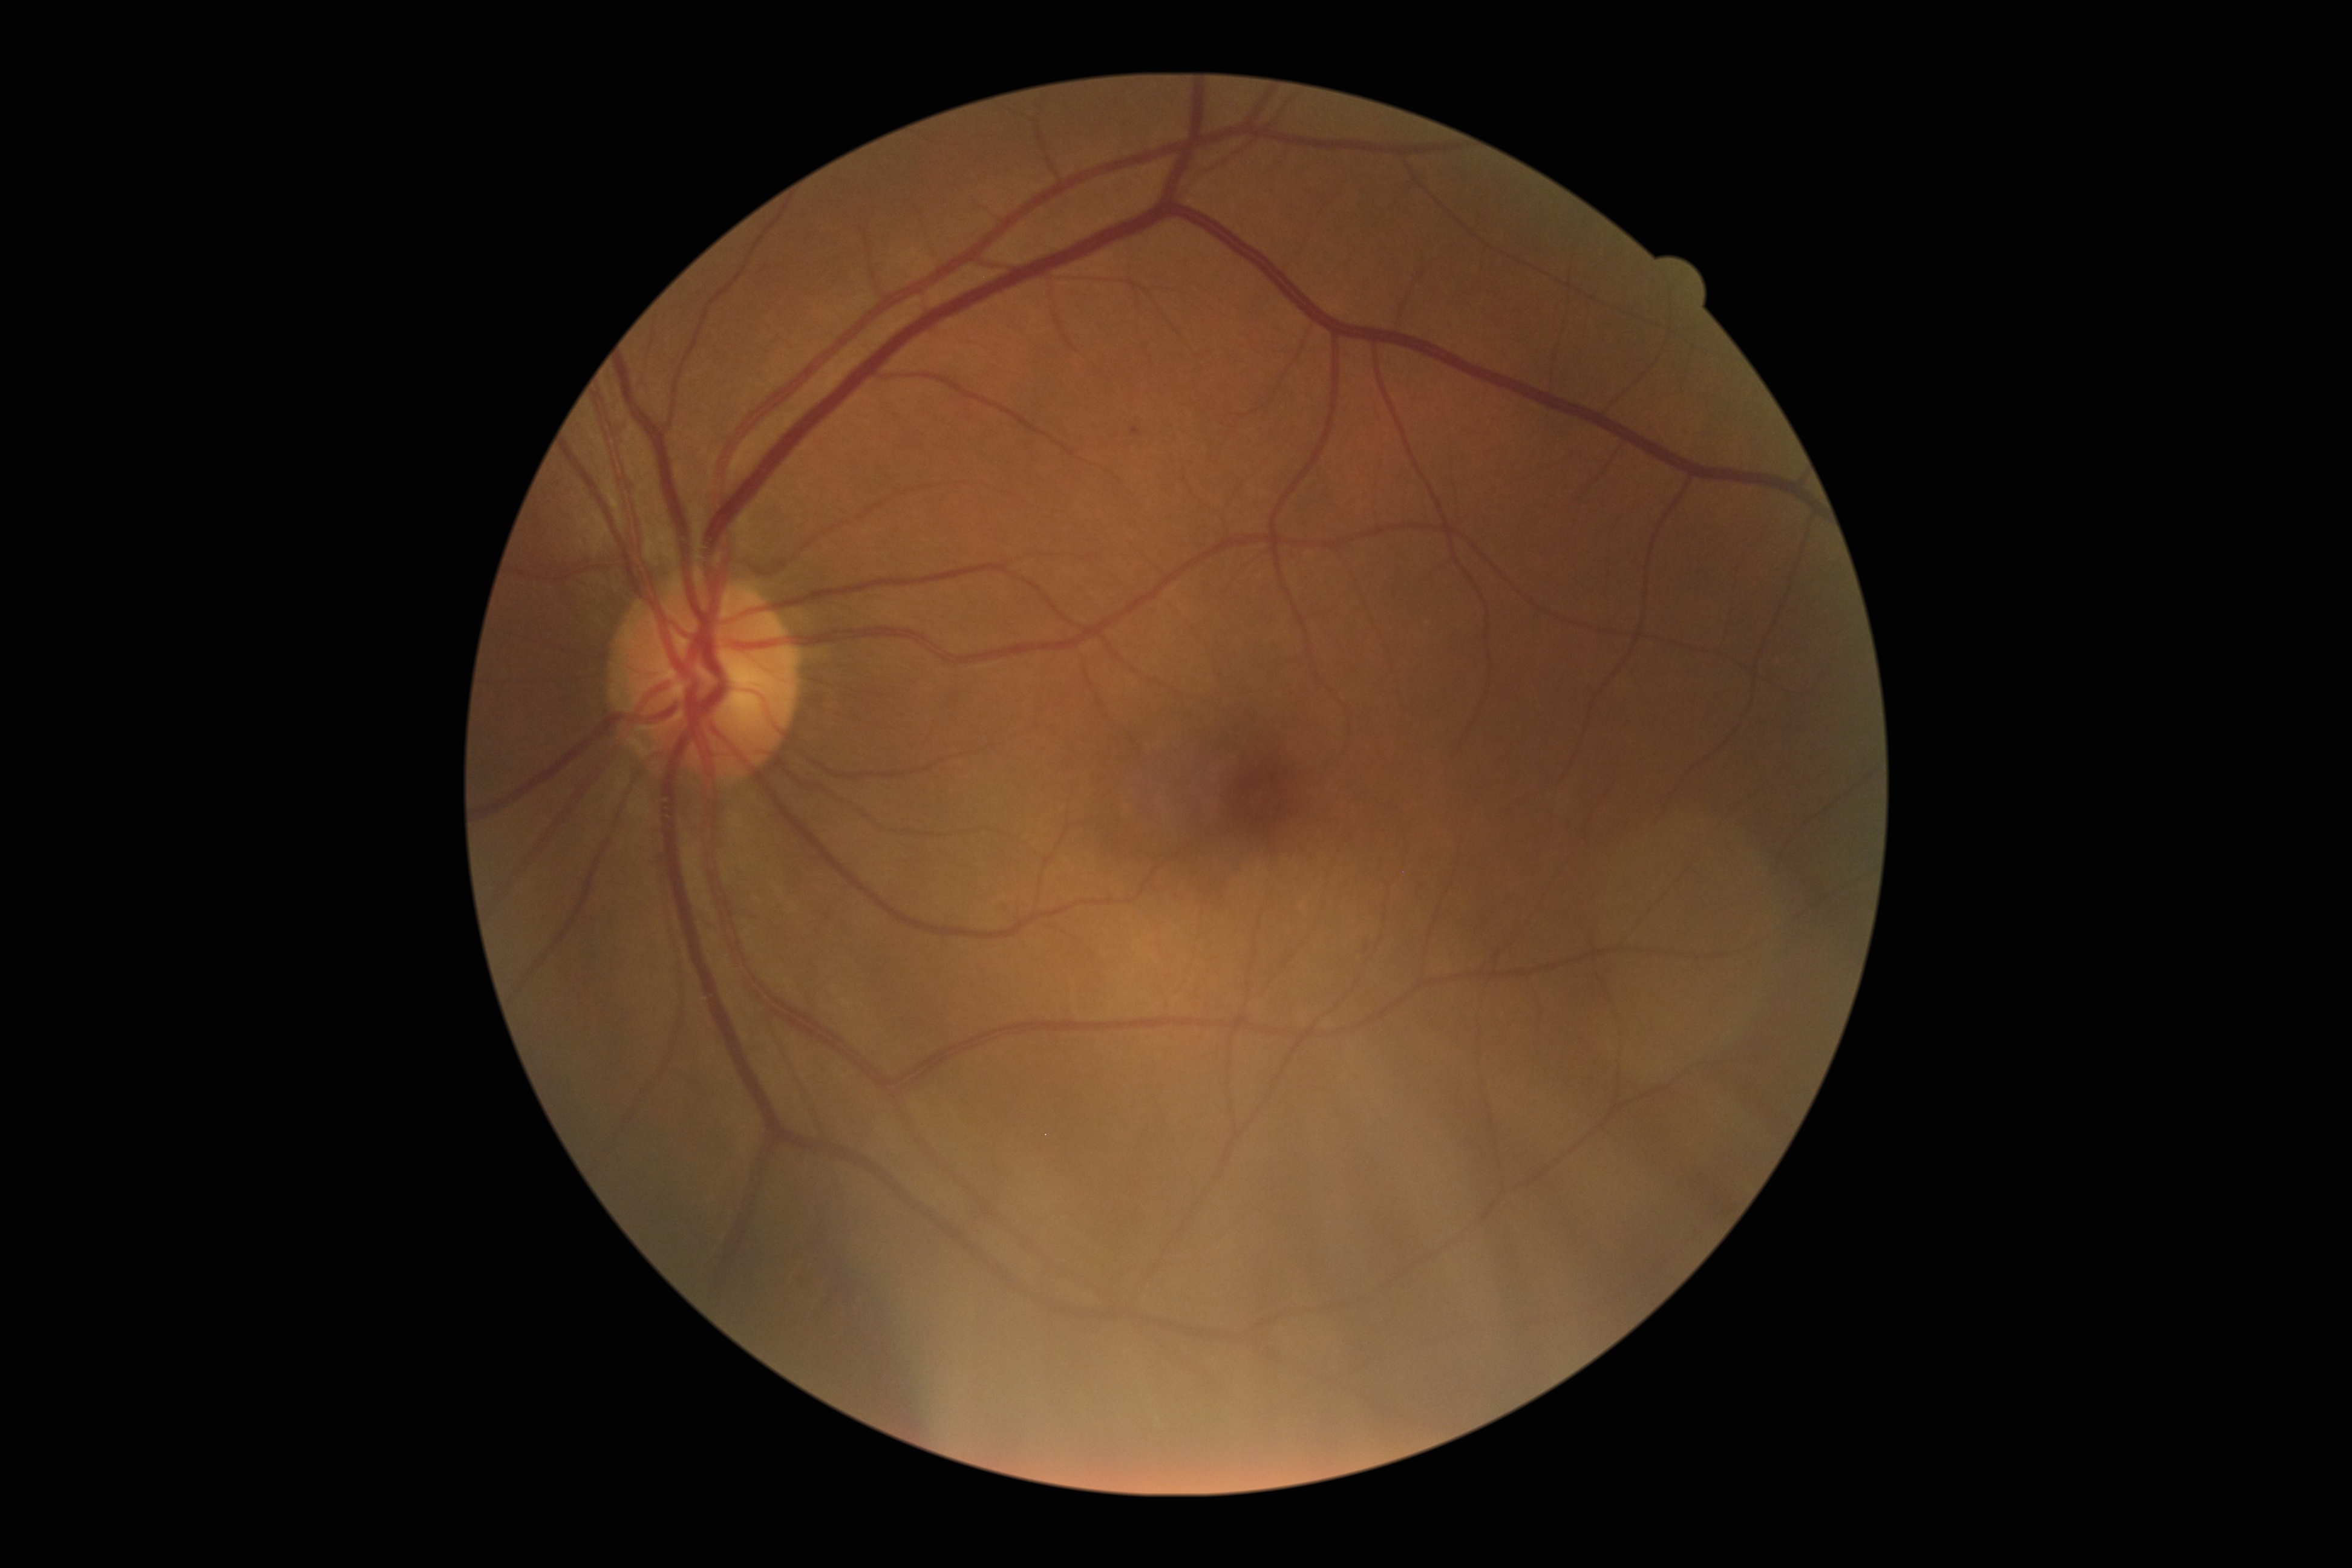

DR grade: mild non-proliferative diabetic retinopathy (1).
The retinopathy is classified as non-proliferative diabetic retinopathy.